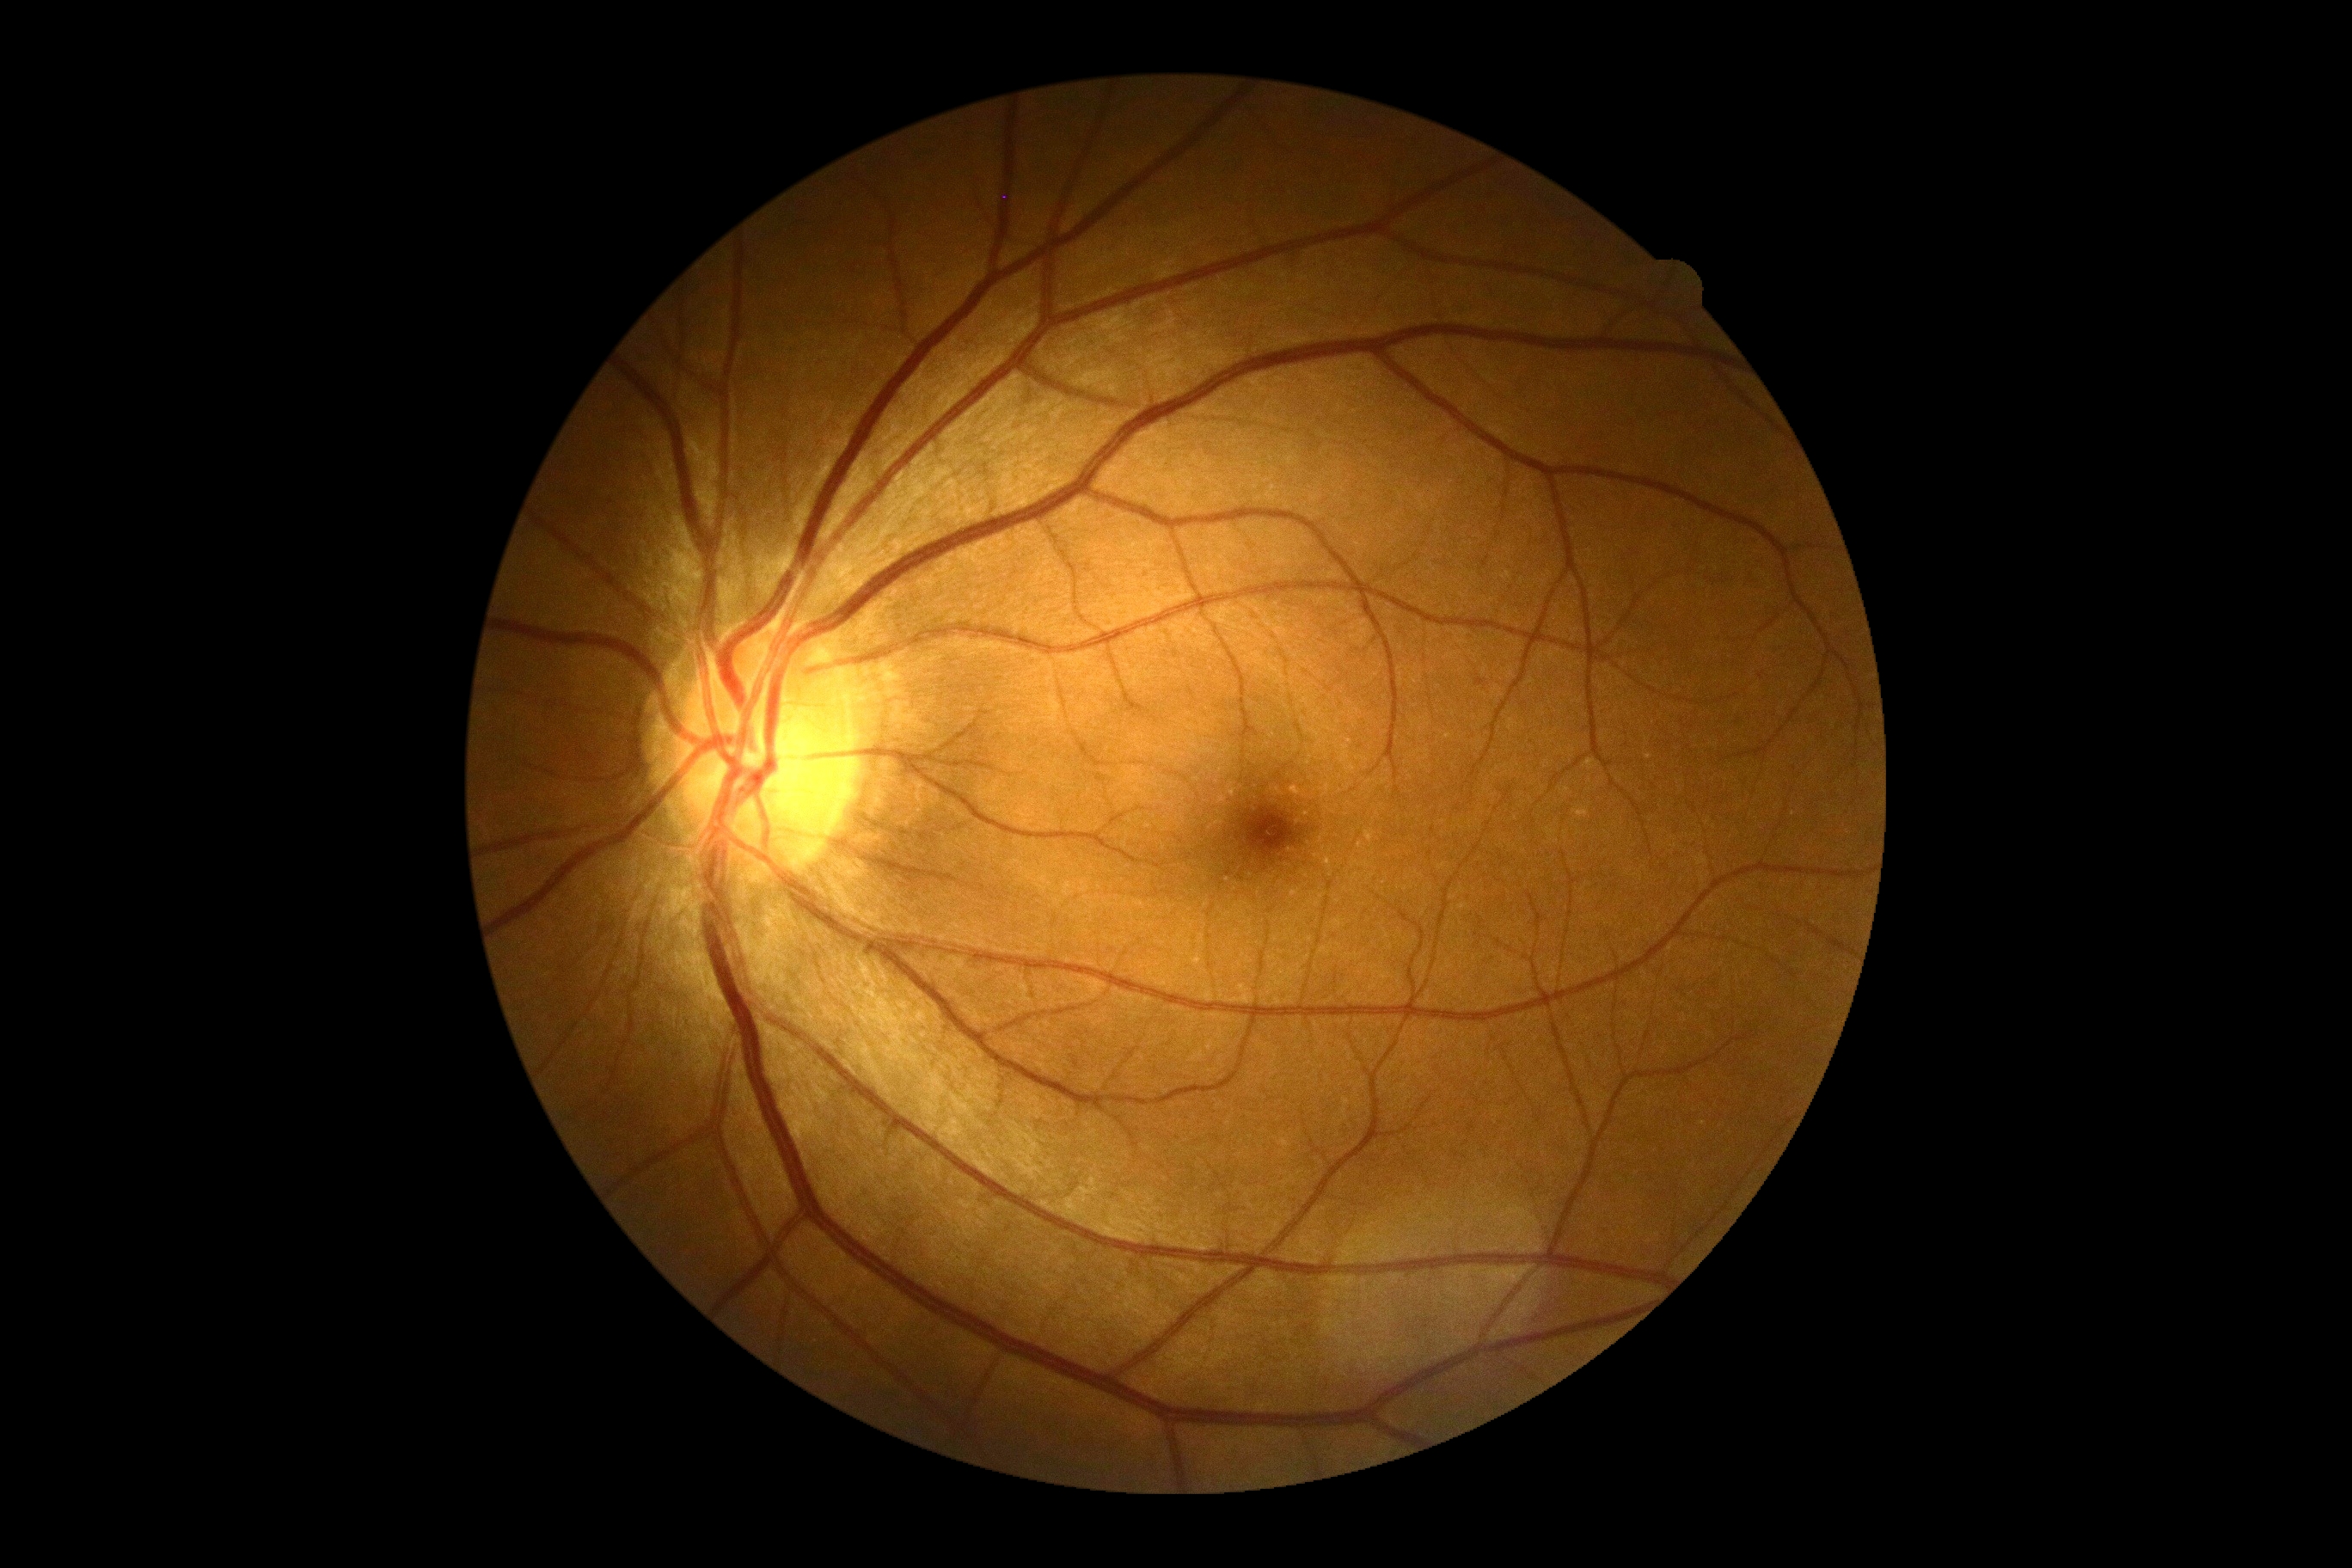 Diabetic retinopathy: no apparent retinopathy (grade 0) — no visible signs of diabetic retinopathy.